60-degree field of view. Fundus photo taken with a portable handheld camera — 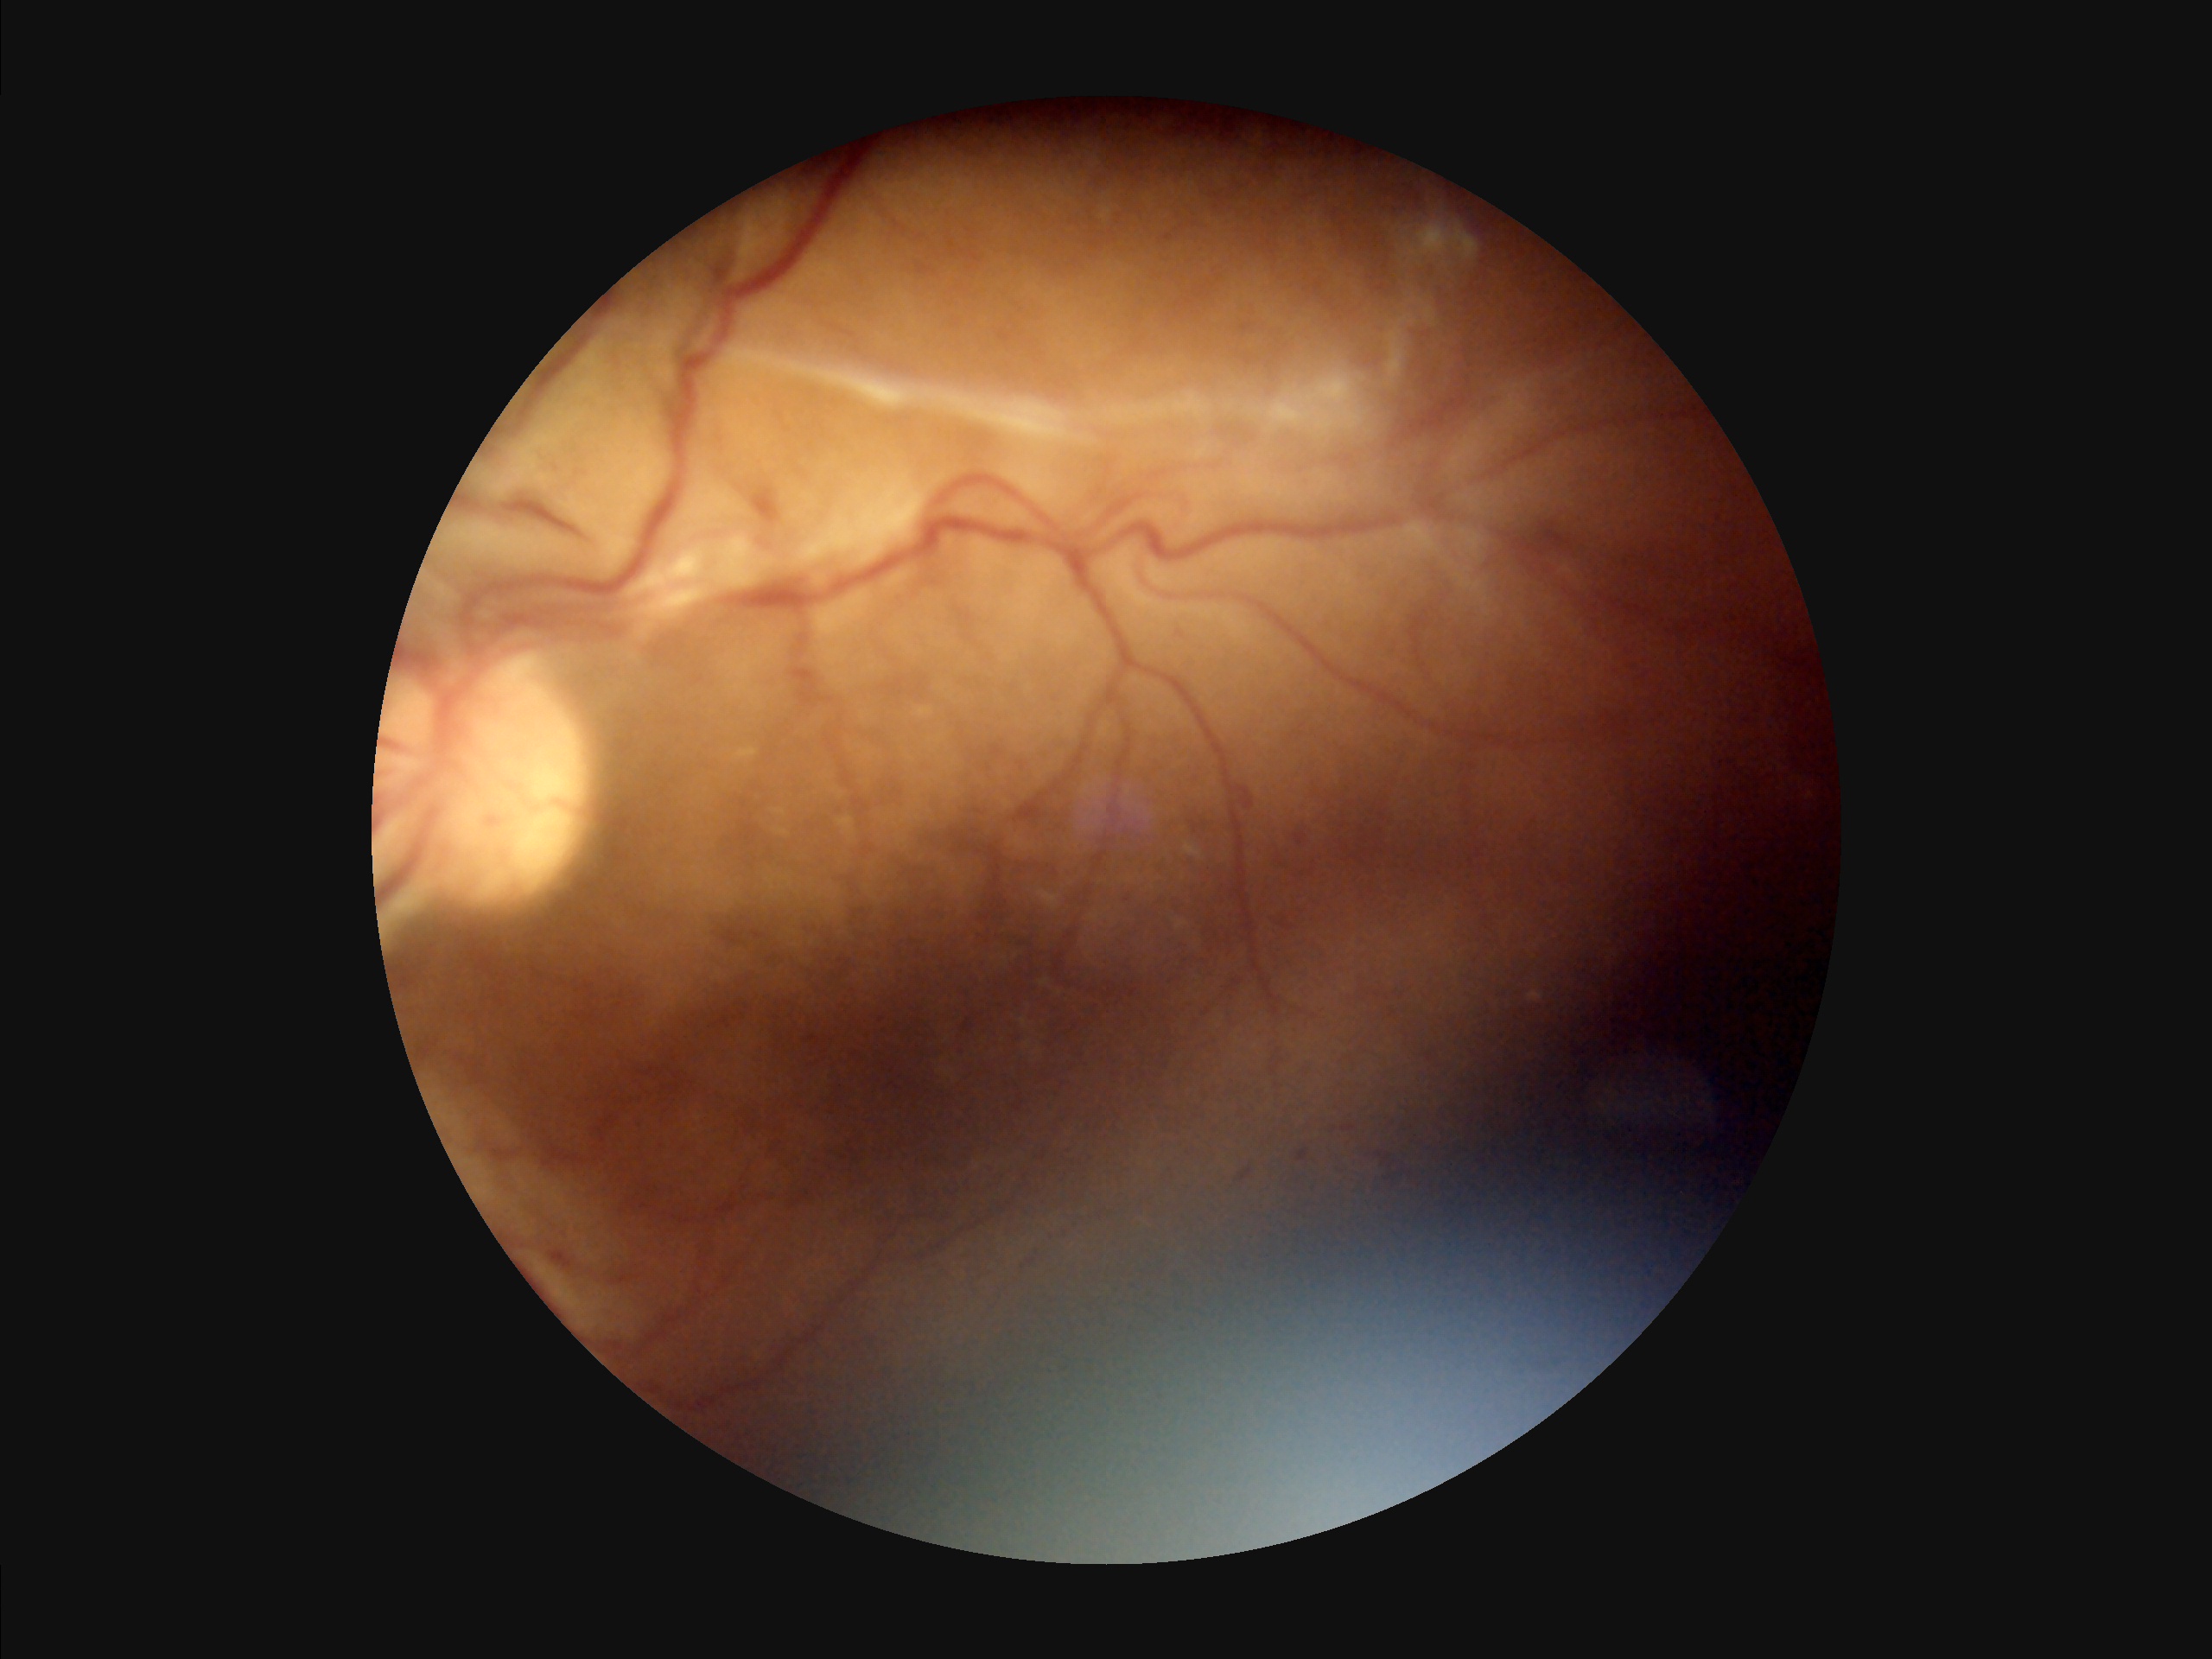 Overall image quality = suboptimal | Contrast = good | Sharpness = reduced | Illumination = suboptimal.